Topcon TRC-NW400; IOP 18 mmHg; FOV: 30 degrees: 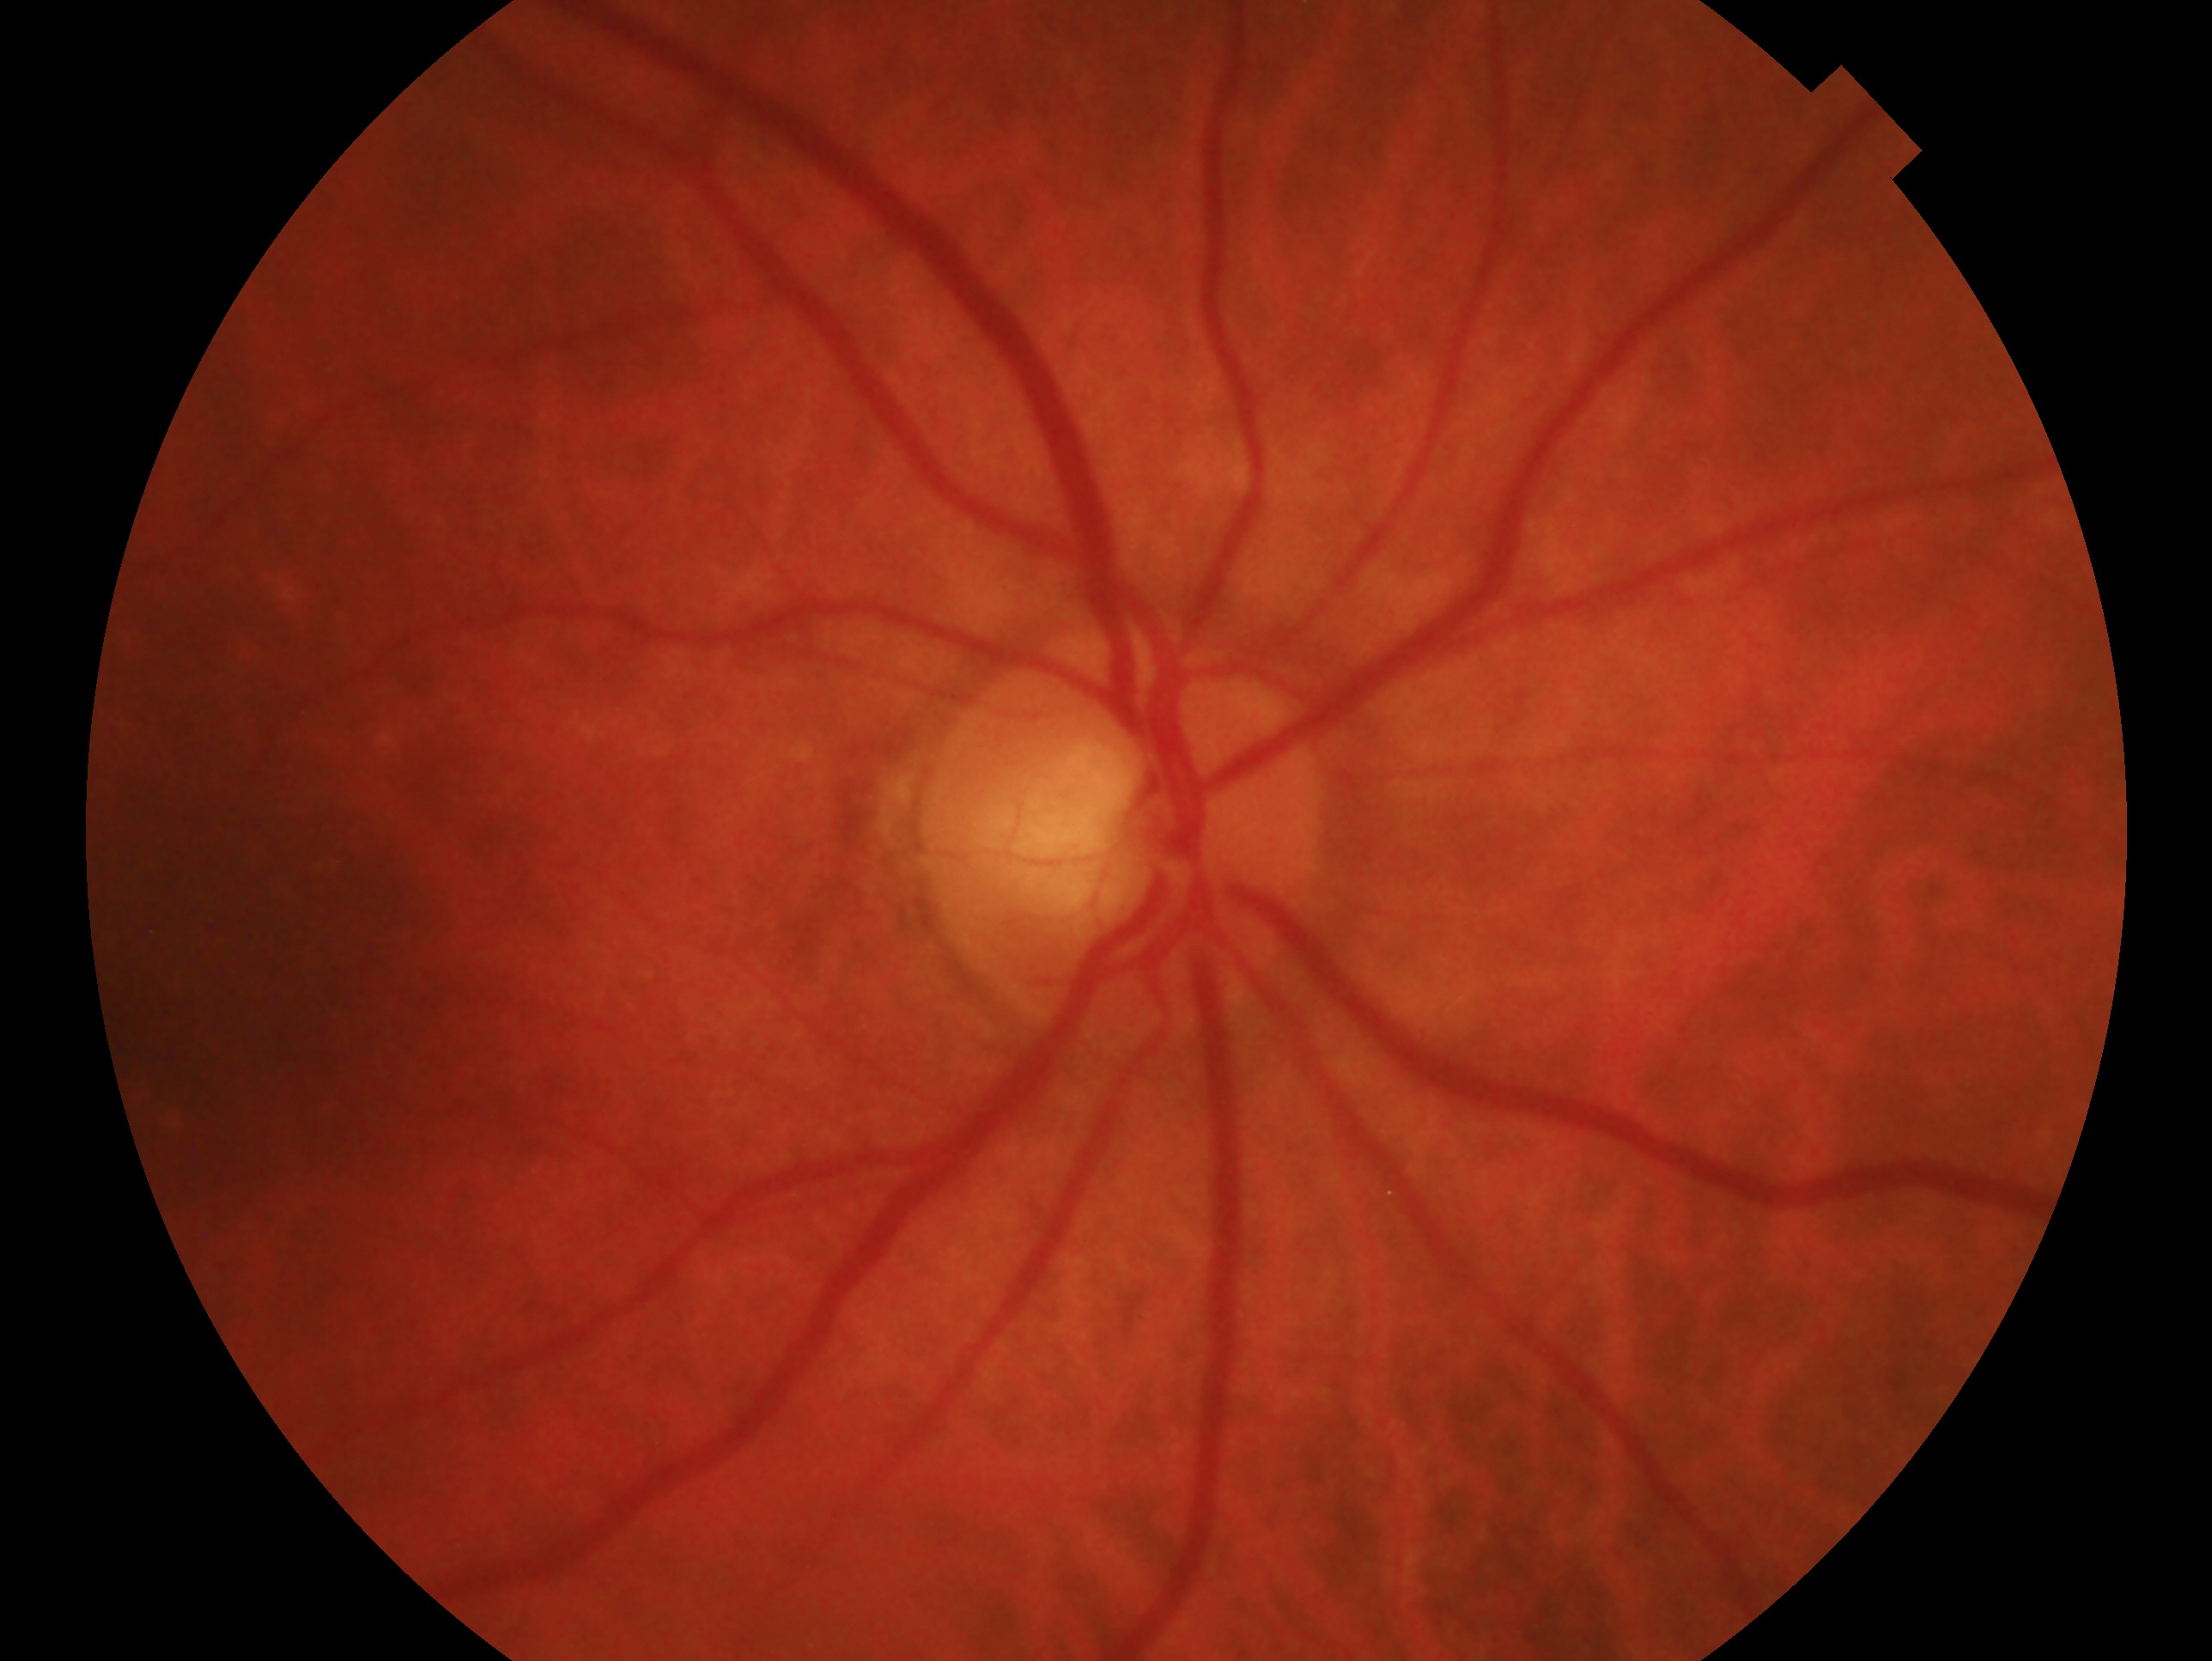

Eye: oculus dexter.
Glaucoma assessment: no signs of glaucoma.